Kowa VX-10α. Image size 2361x1568. 50° field of view: 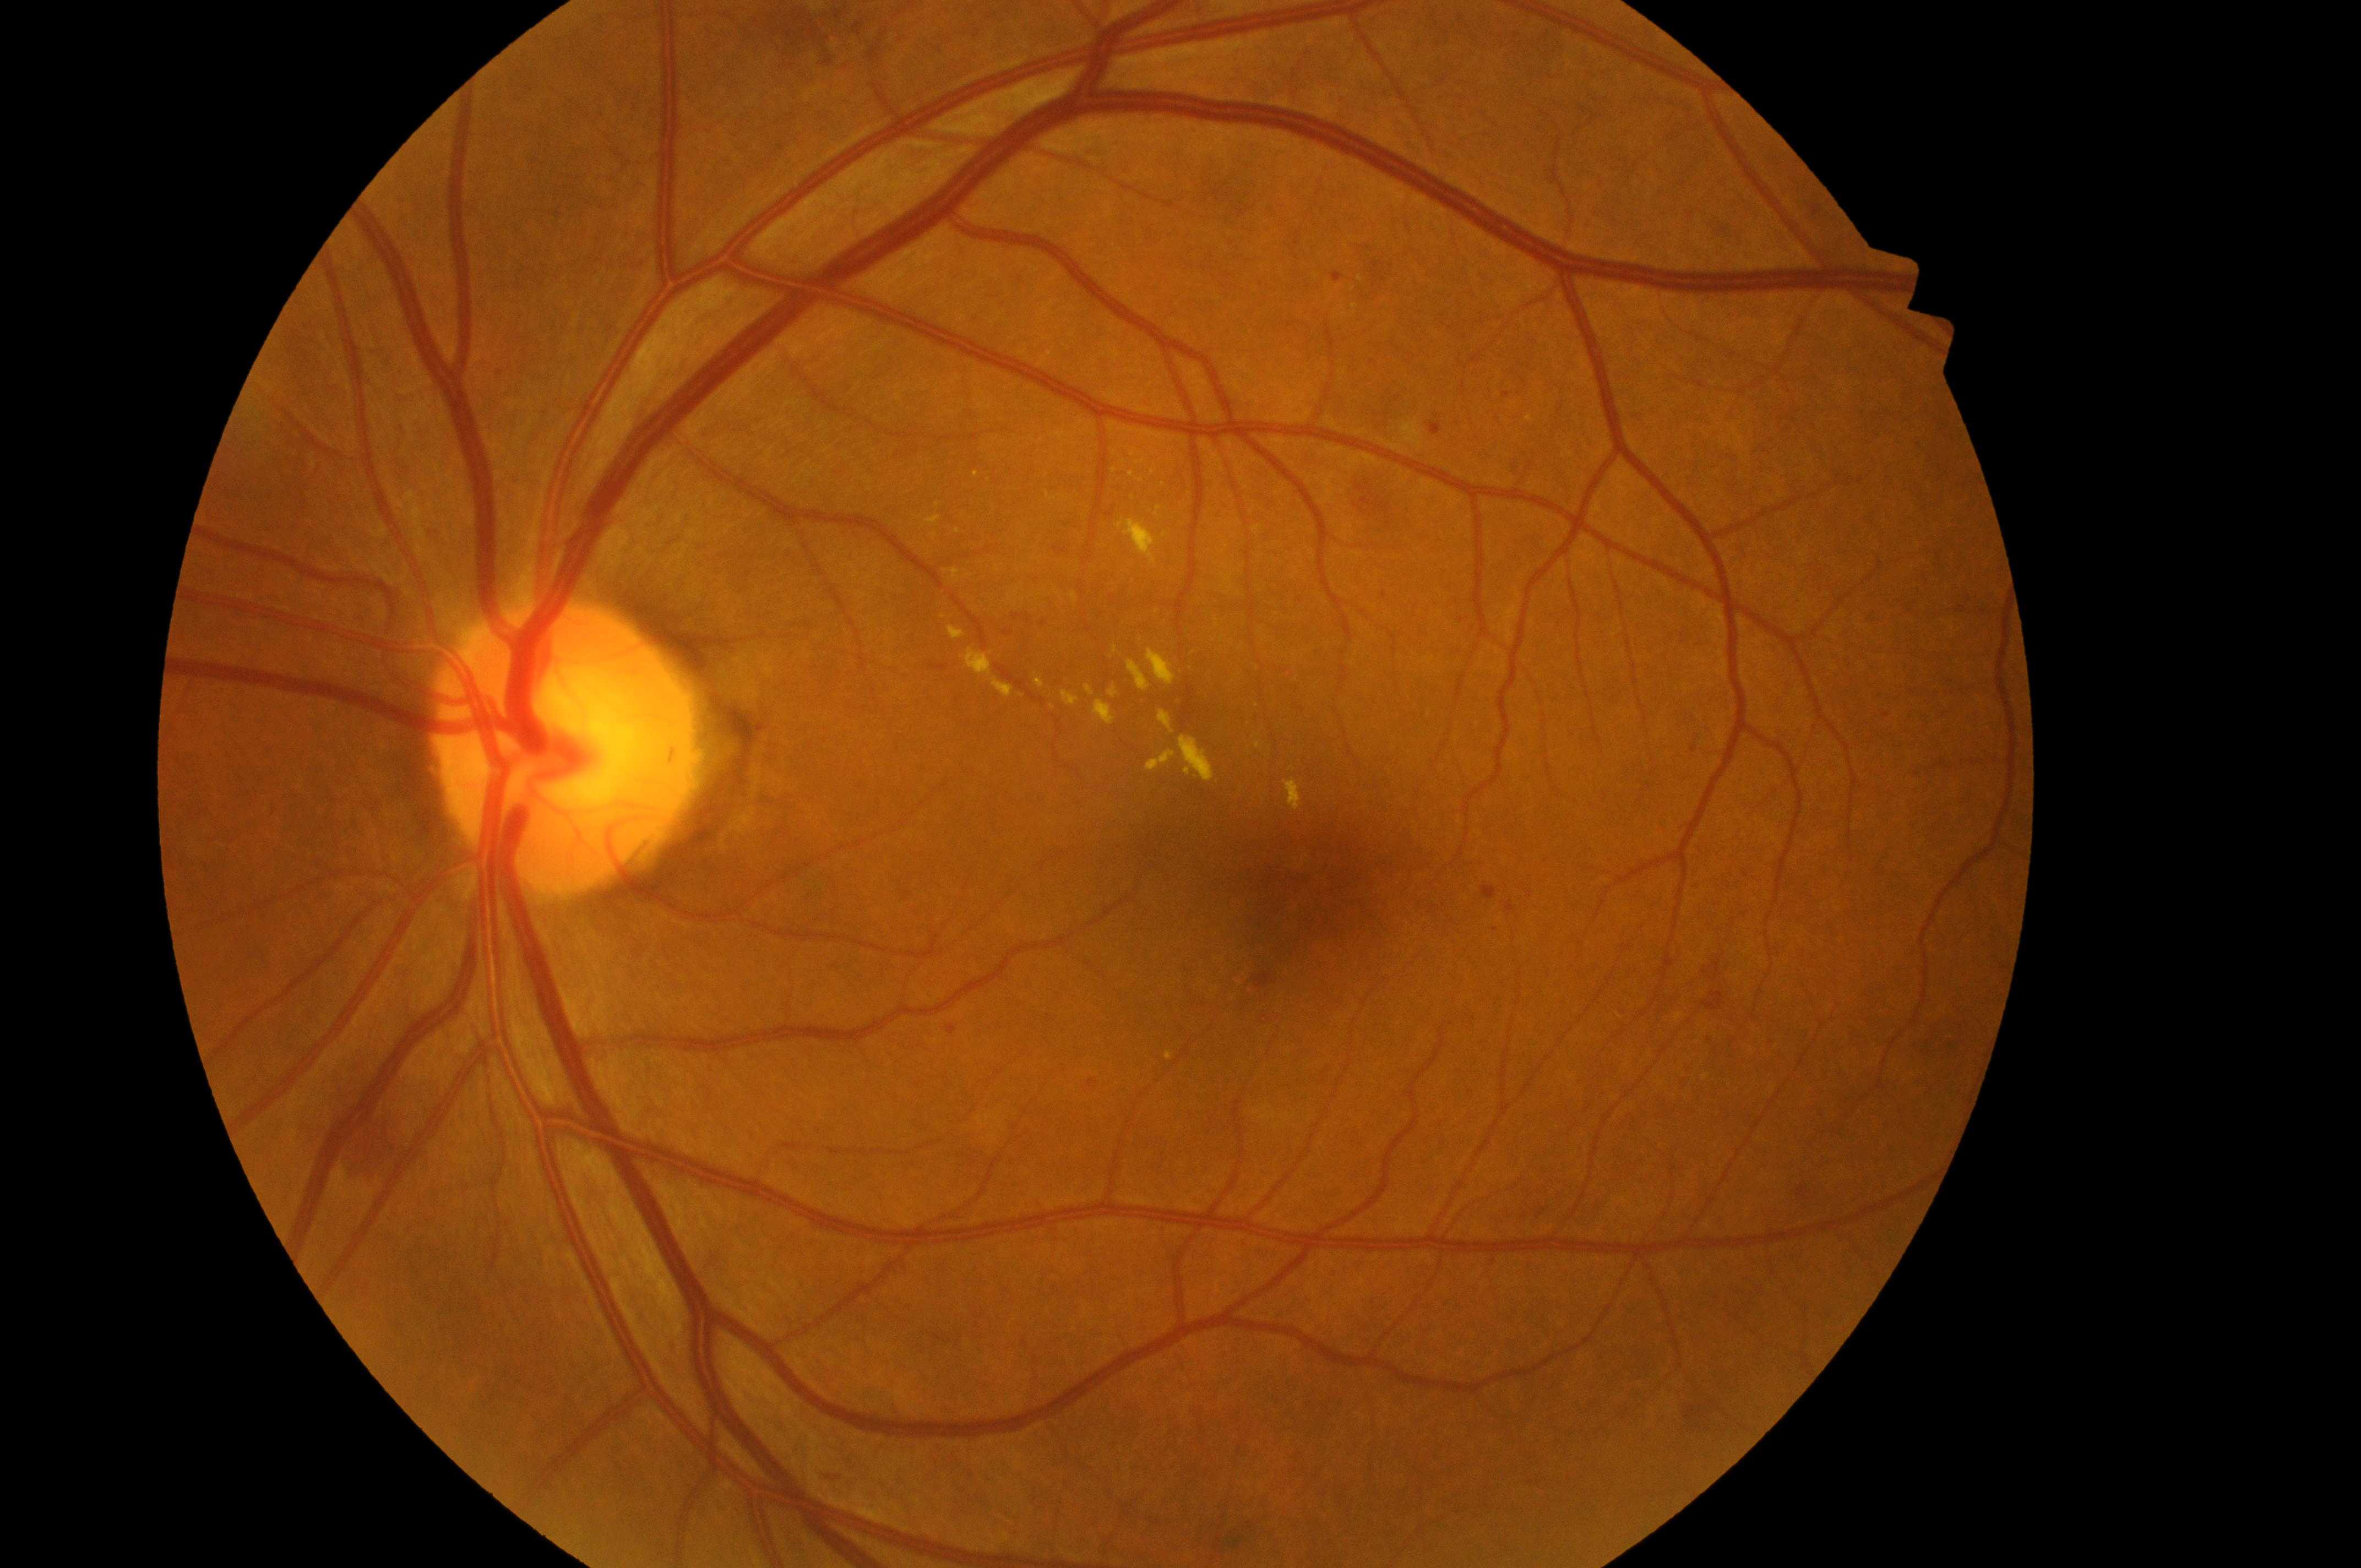
  optic_disc: 563px, 750px
  fovea: 1320px, 890px
  dme_grade: 2
  eye: OS
  dr_grade: 2